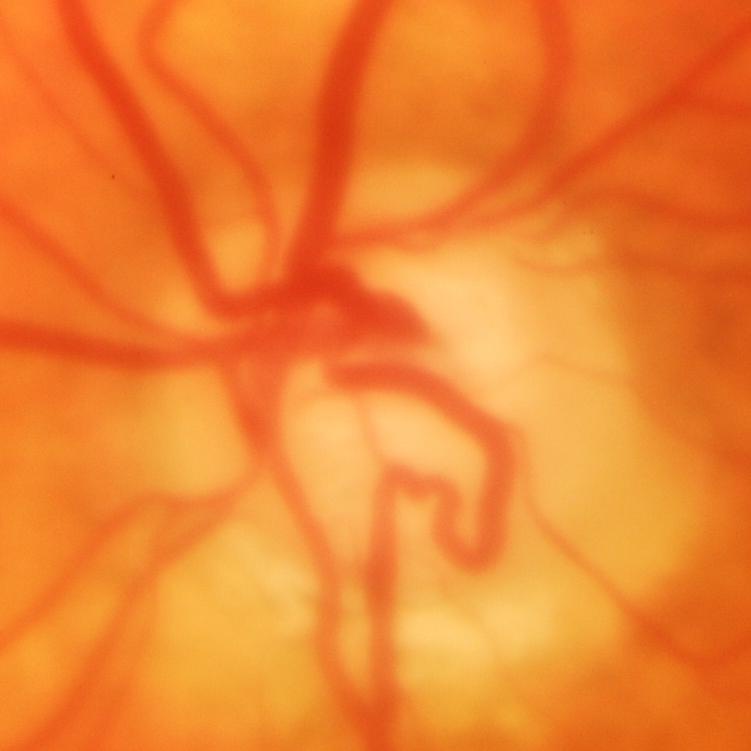

ONH-centered fundus image showing glaucoma.